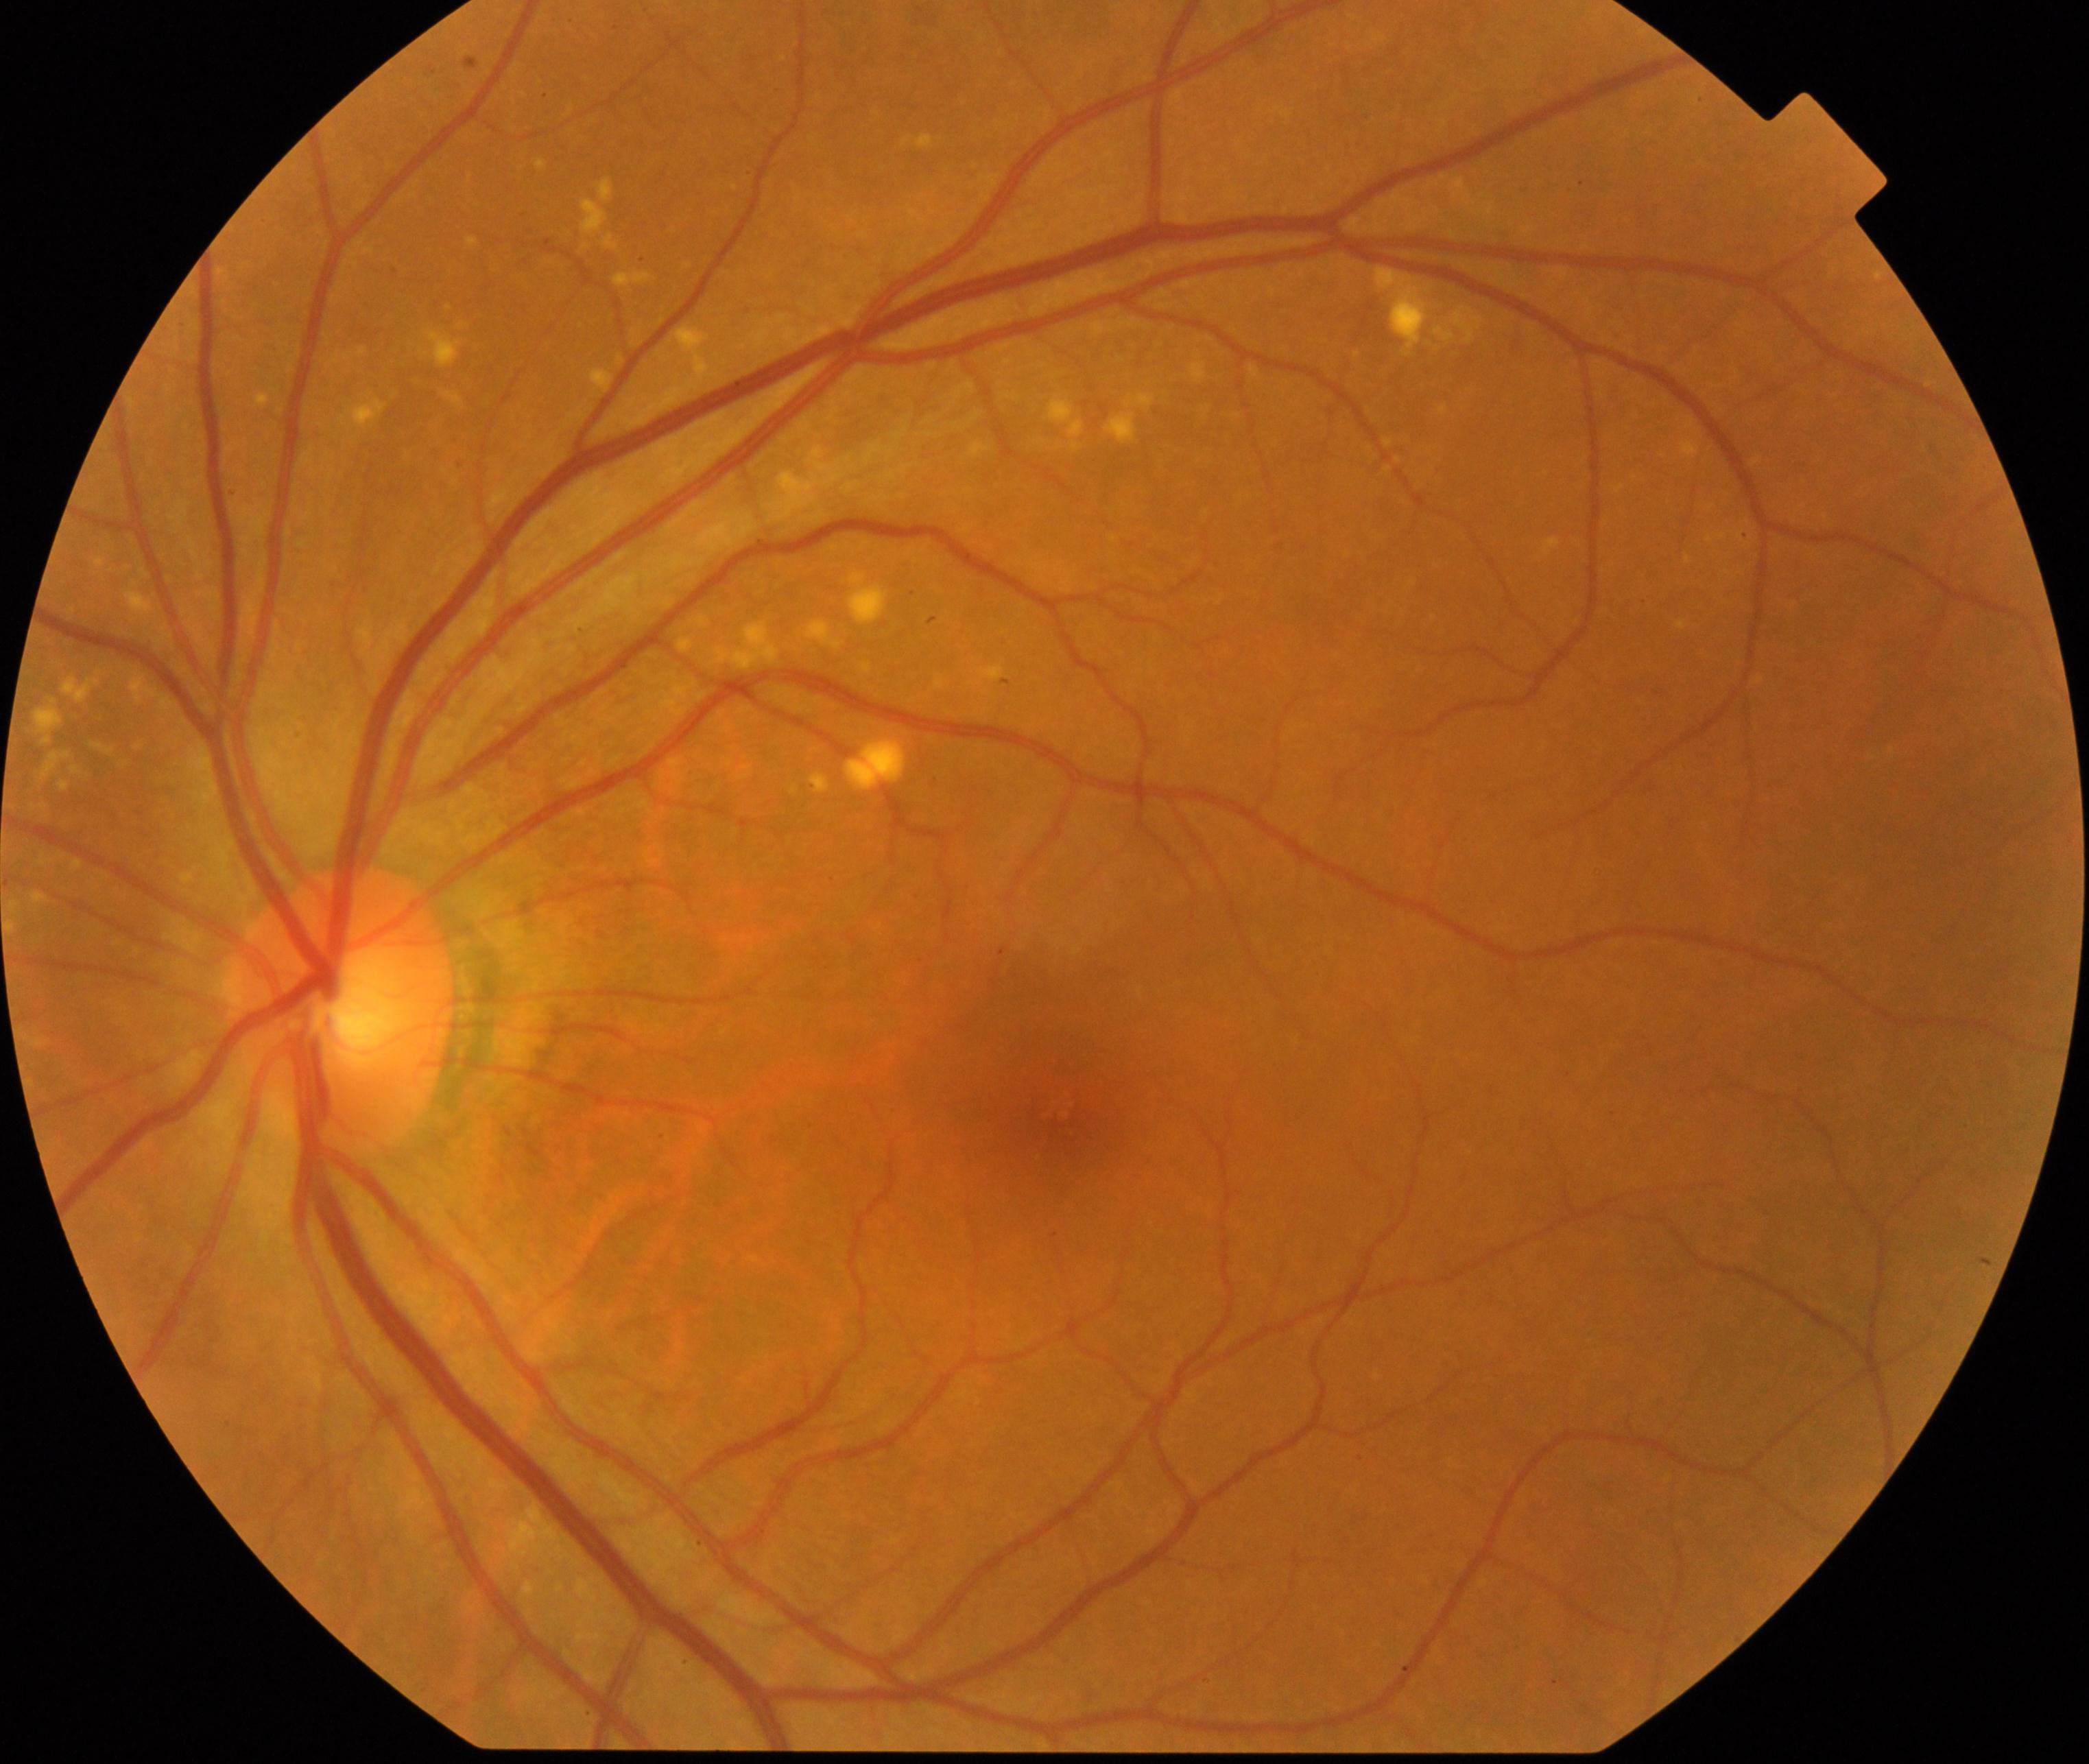
Diagnosis: yellow-white spots or flecks. Features include multiple, discrete, yellow-white round dots or polymorphous fleck lesions, including early age-related macular degeneration (drusen <125 µm).